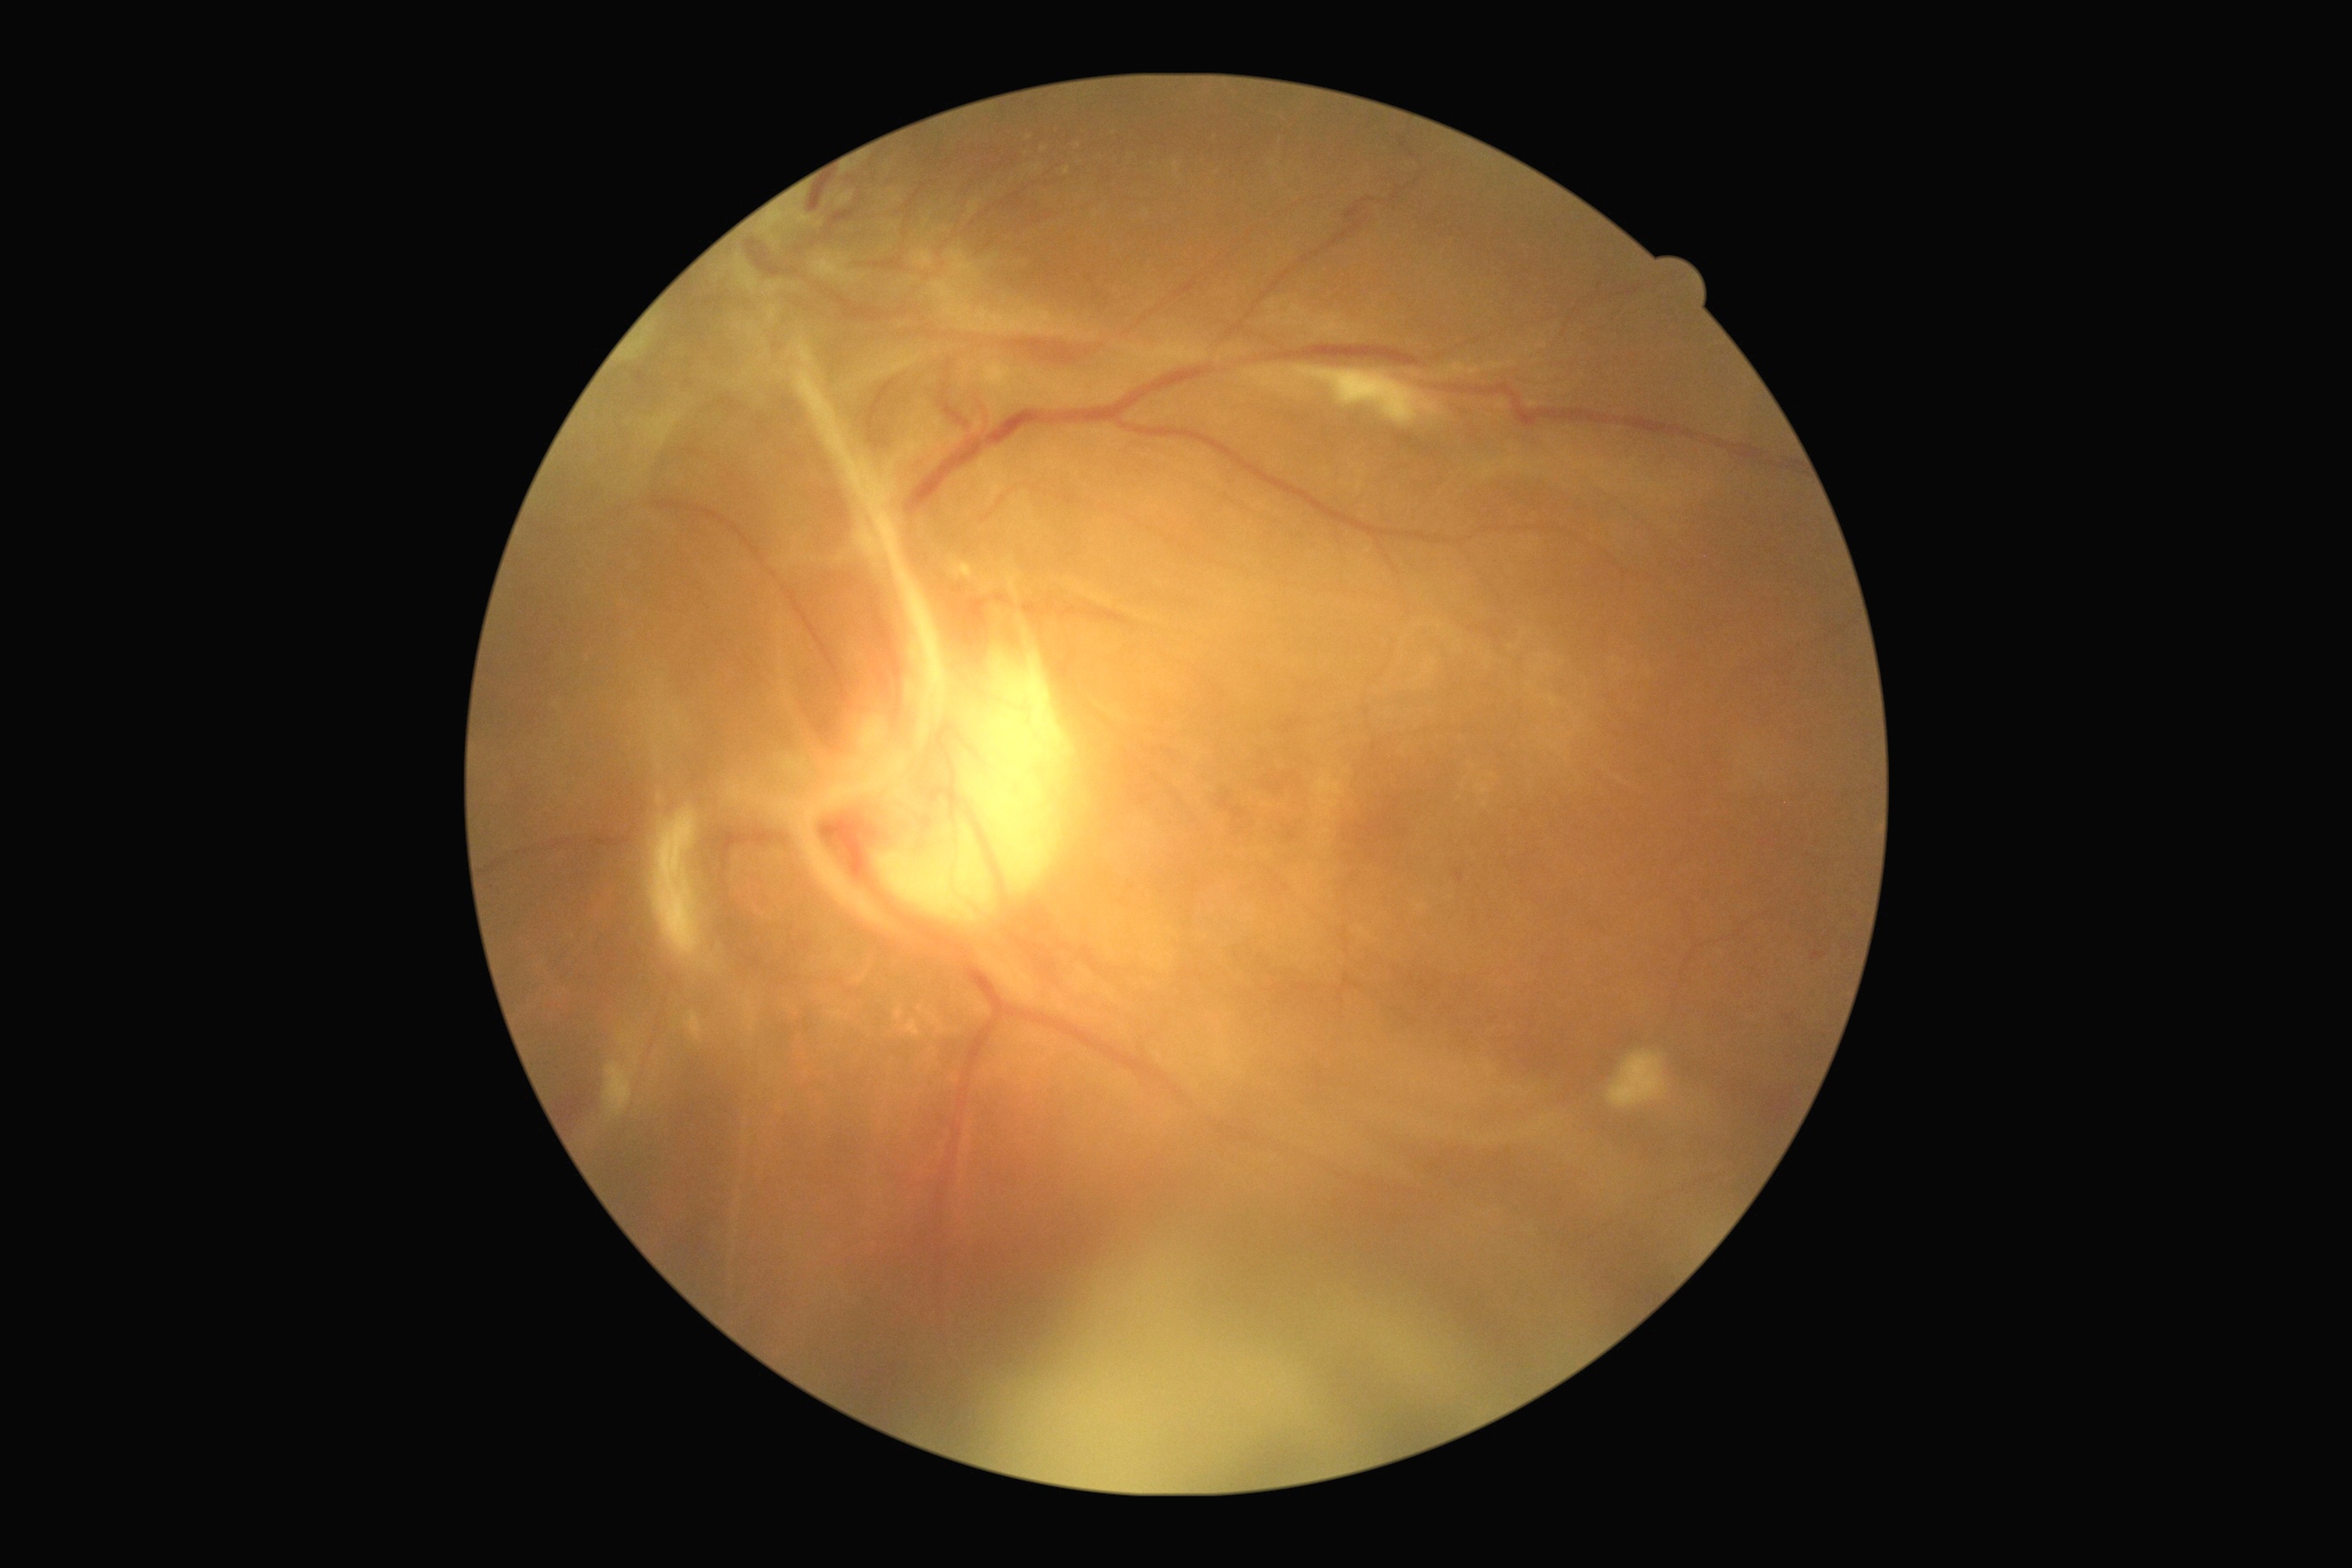
DR severity: grade 4.